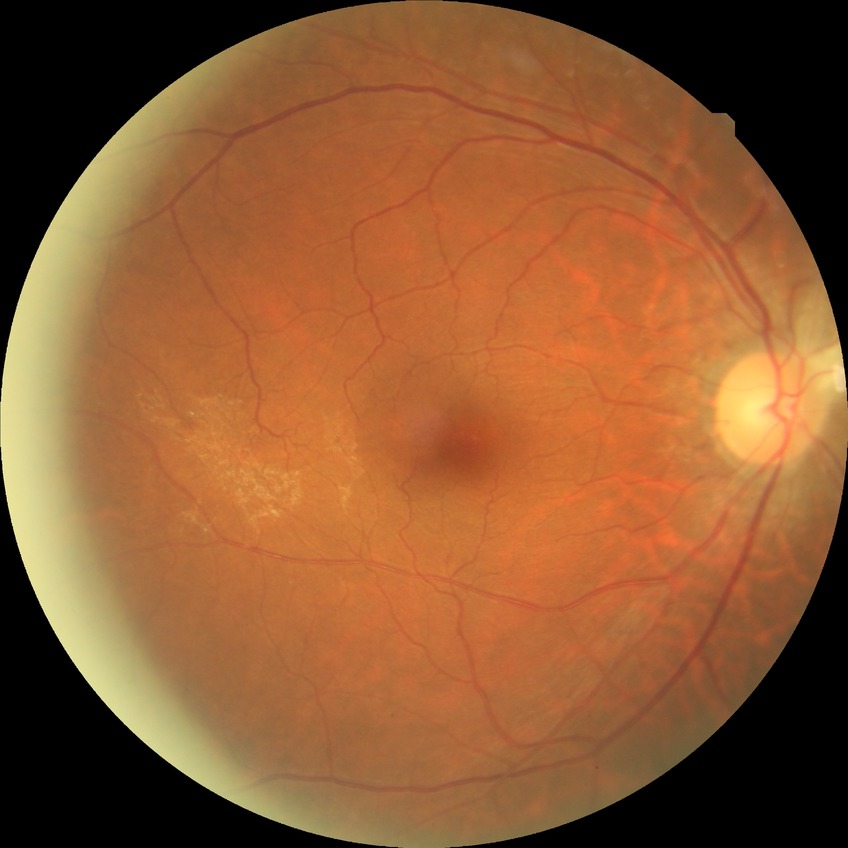

Diabetic retinopathy (DR): no diabetic retinopathy (NDR).